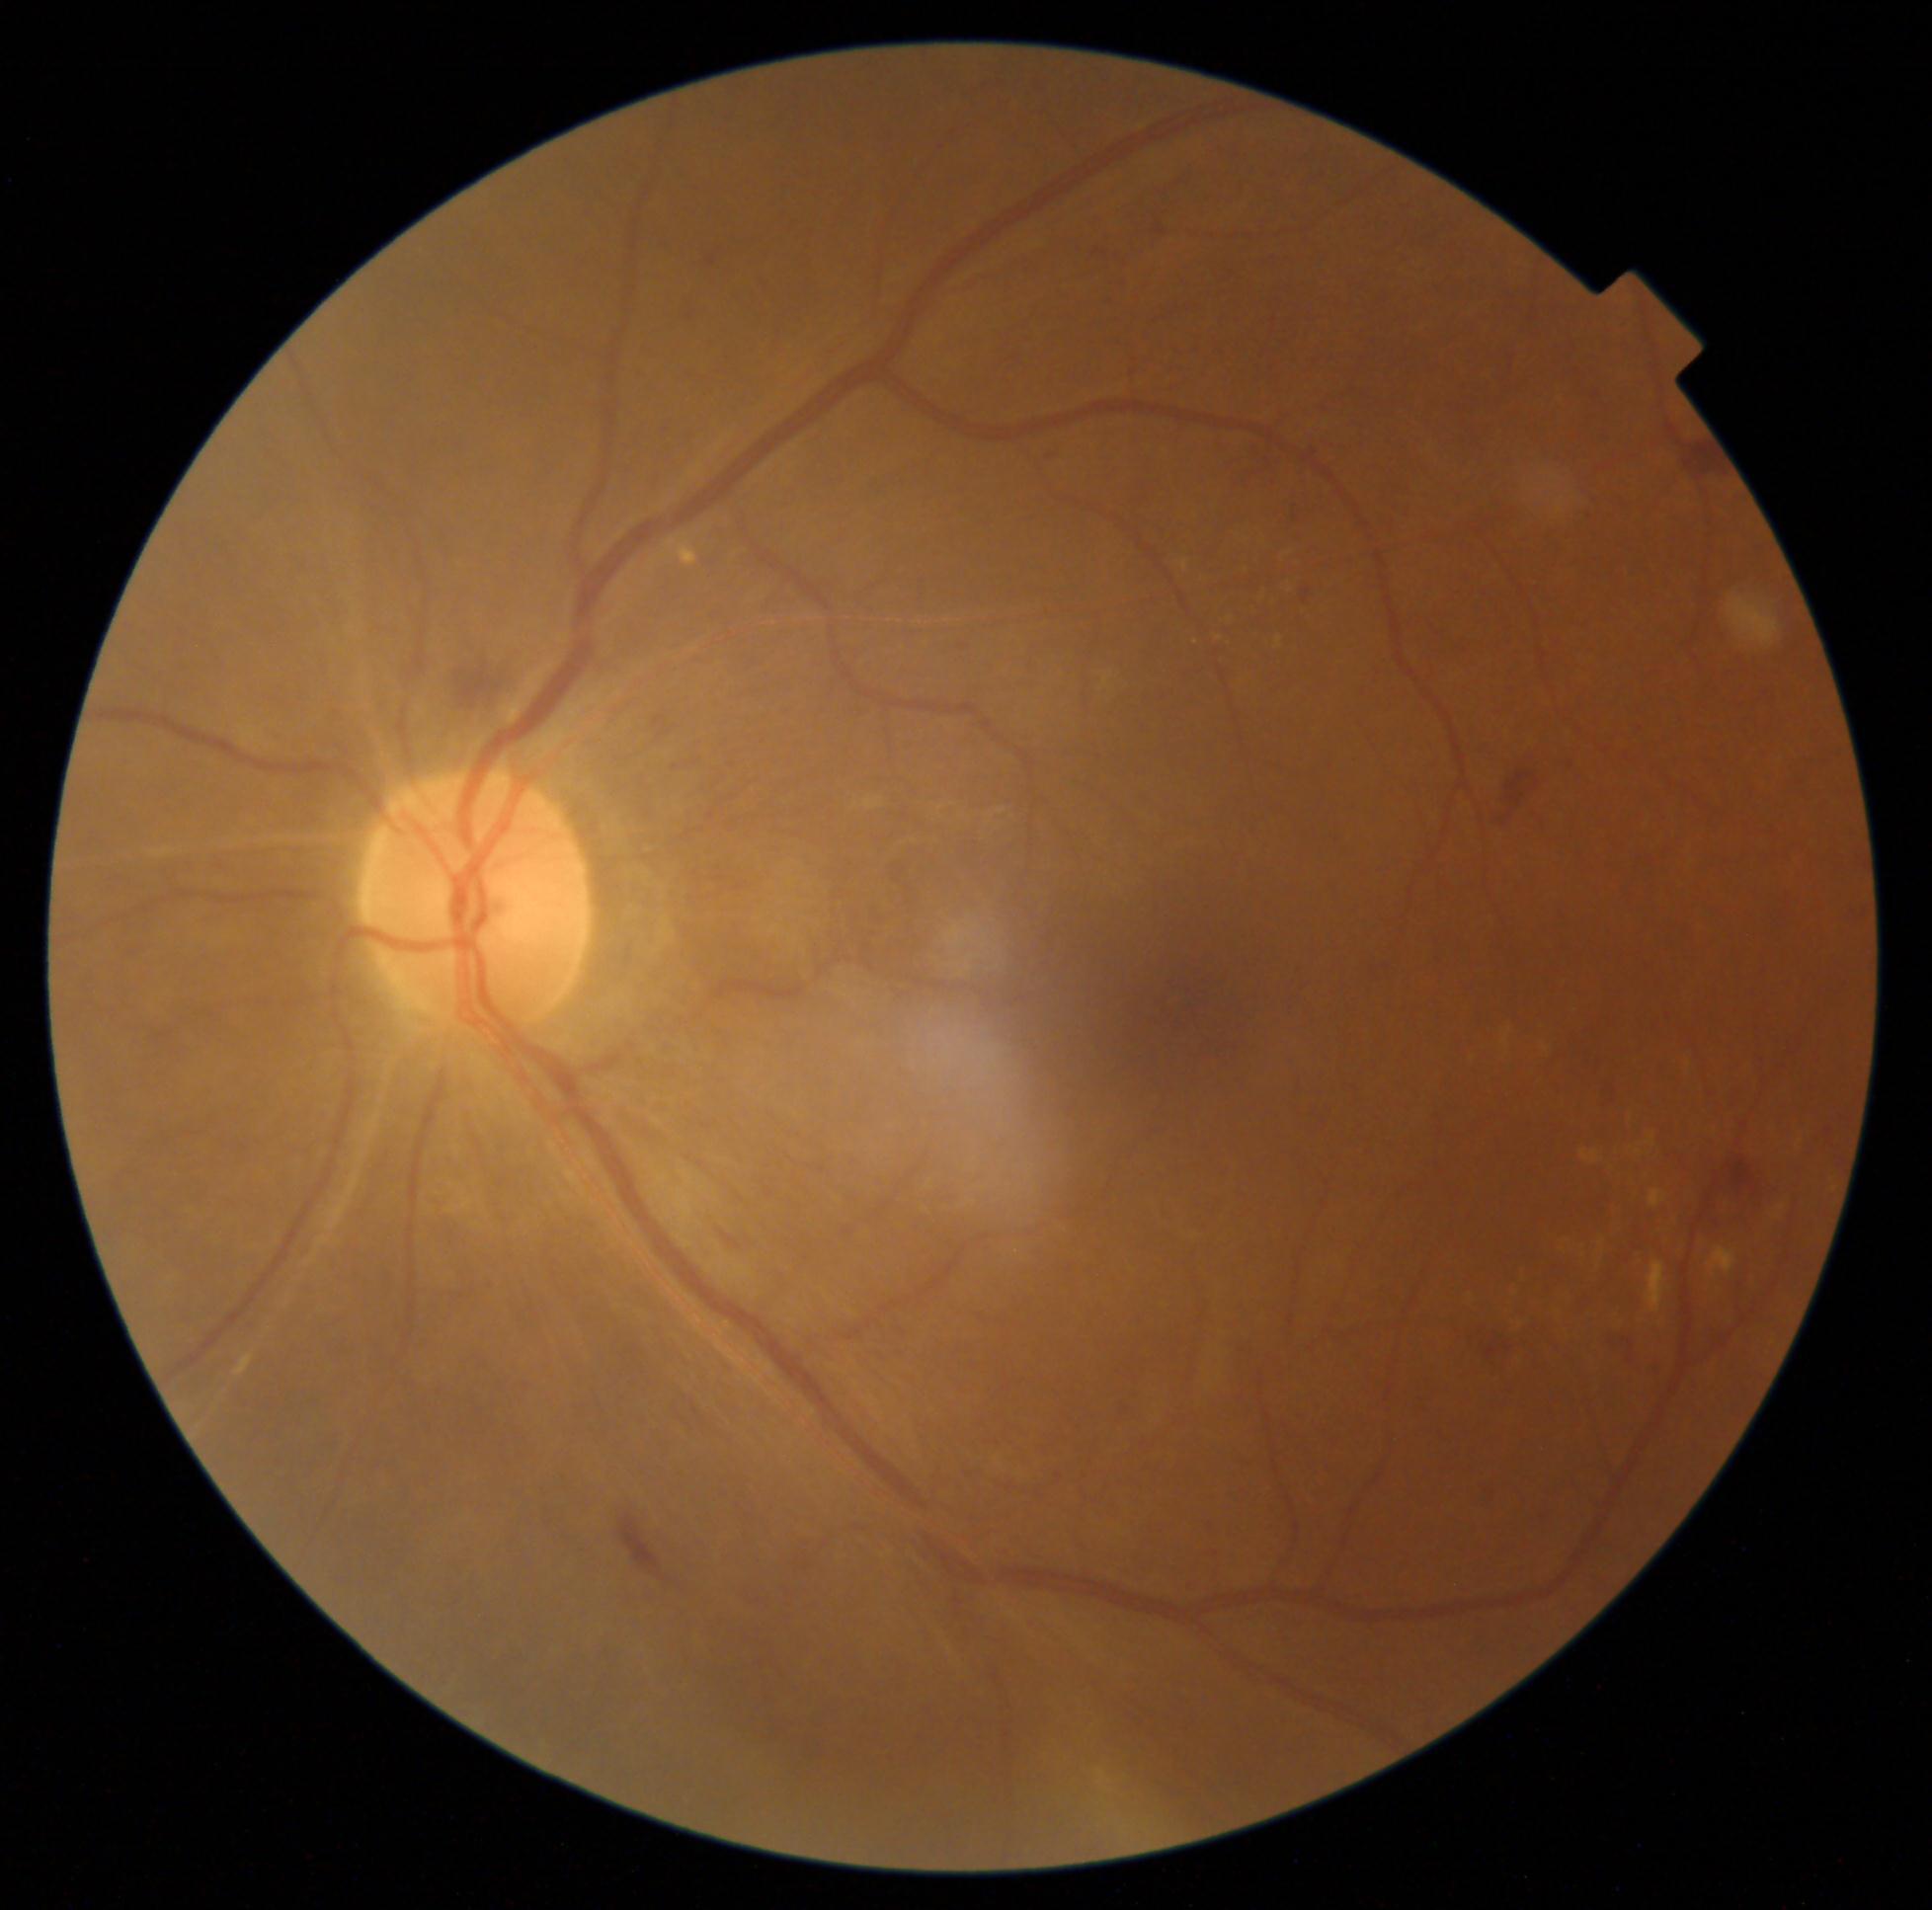
DR stage is moderate NPDR (grade 2)
Lesions identified (partial list):
SEs = none detected
EXs (more not shown) = 1708 1247 1736 1273 | 1646 1135 1655 1148 | 1181 560 1190 571 | 1778 1205 1787 1212 | 659 535 698 568 | 1217 636 1225 641 | 1650 1190 1666 1208
Small EXs near (1777,1216) | (1516,1294) | (1196,643) | (1690,1065)
MAs = none detected
HEs = 1597 1081 1620 1106 | 1457 1326 1523 1375 | 679 304 698 326 | 1474 757 1556 833 | 1602 1335 1642 1367 | 1223 438 1309 493 | 1683 432 1731 480 | 1294 582 1316 612 | 1703 1151 1779 1236 | 437 650 533 713 | 646 712 685 745 | 615 1514 690 1591 | 1560 757 1577 771 | 705 255 721 275 | 1694 1326 1728 1355 | 1042 449 1063 462
Small HEs near (1829,1132)